2352 by 1568 pixels — 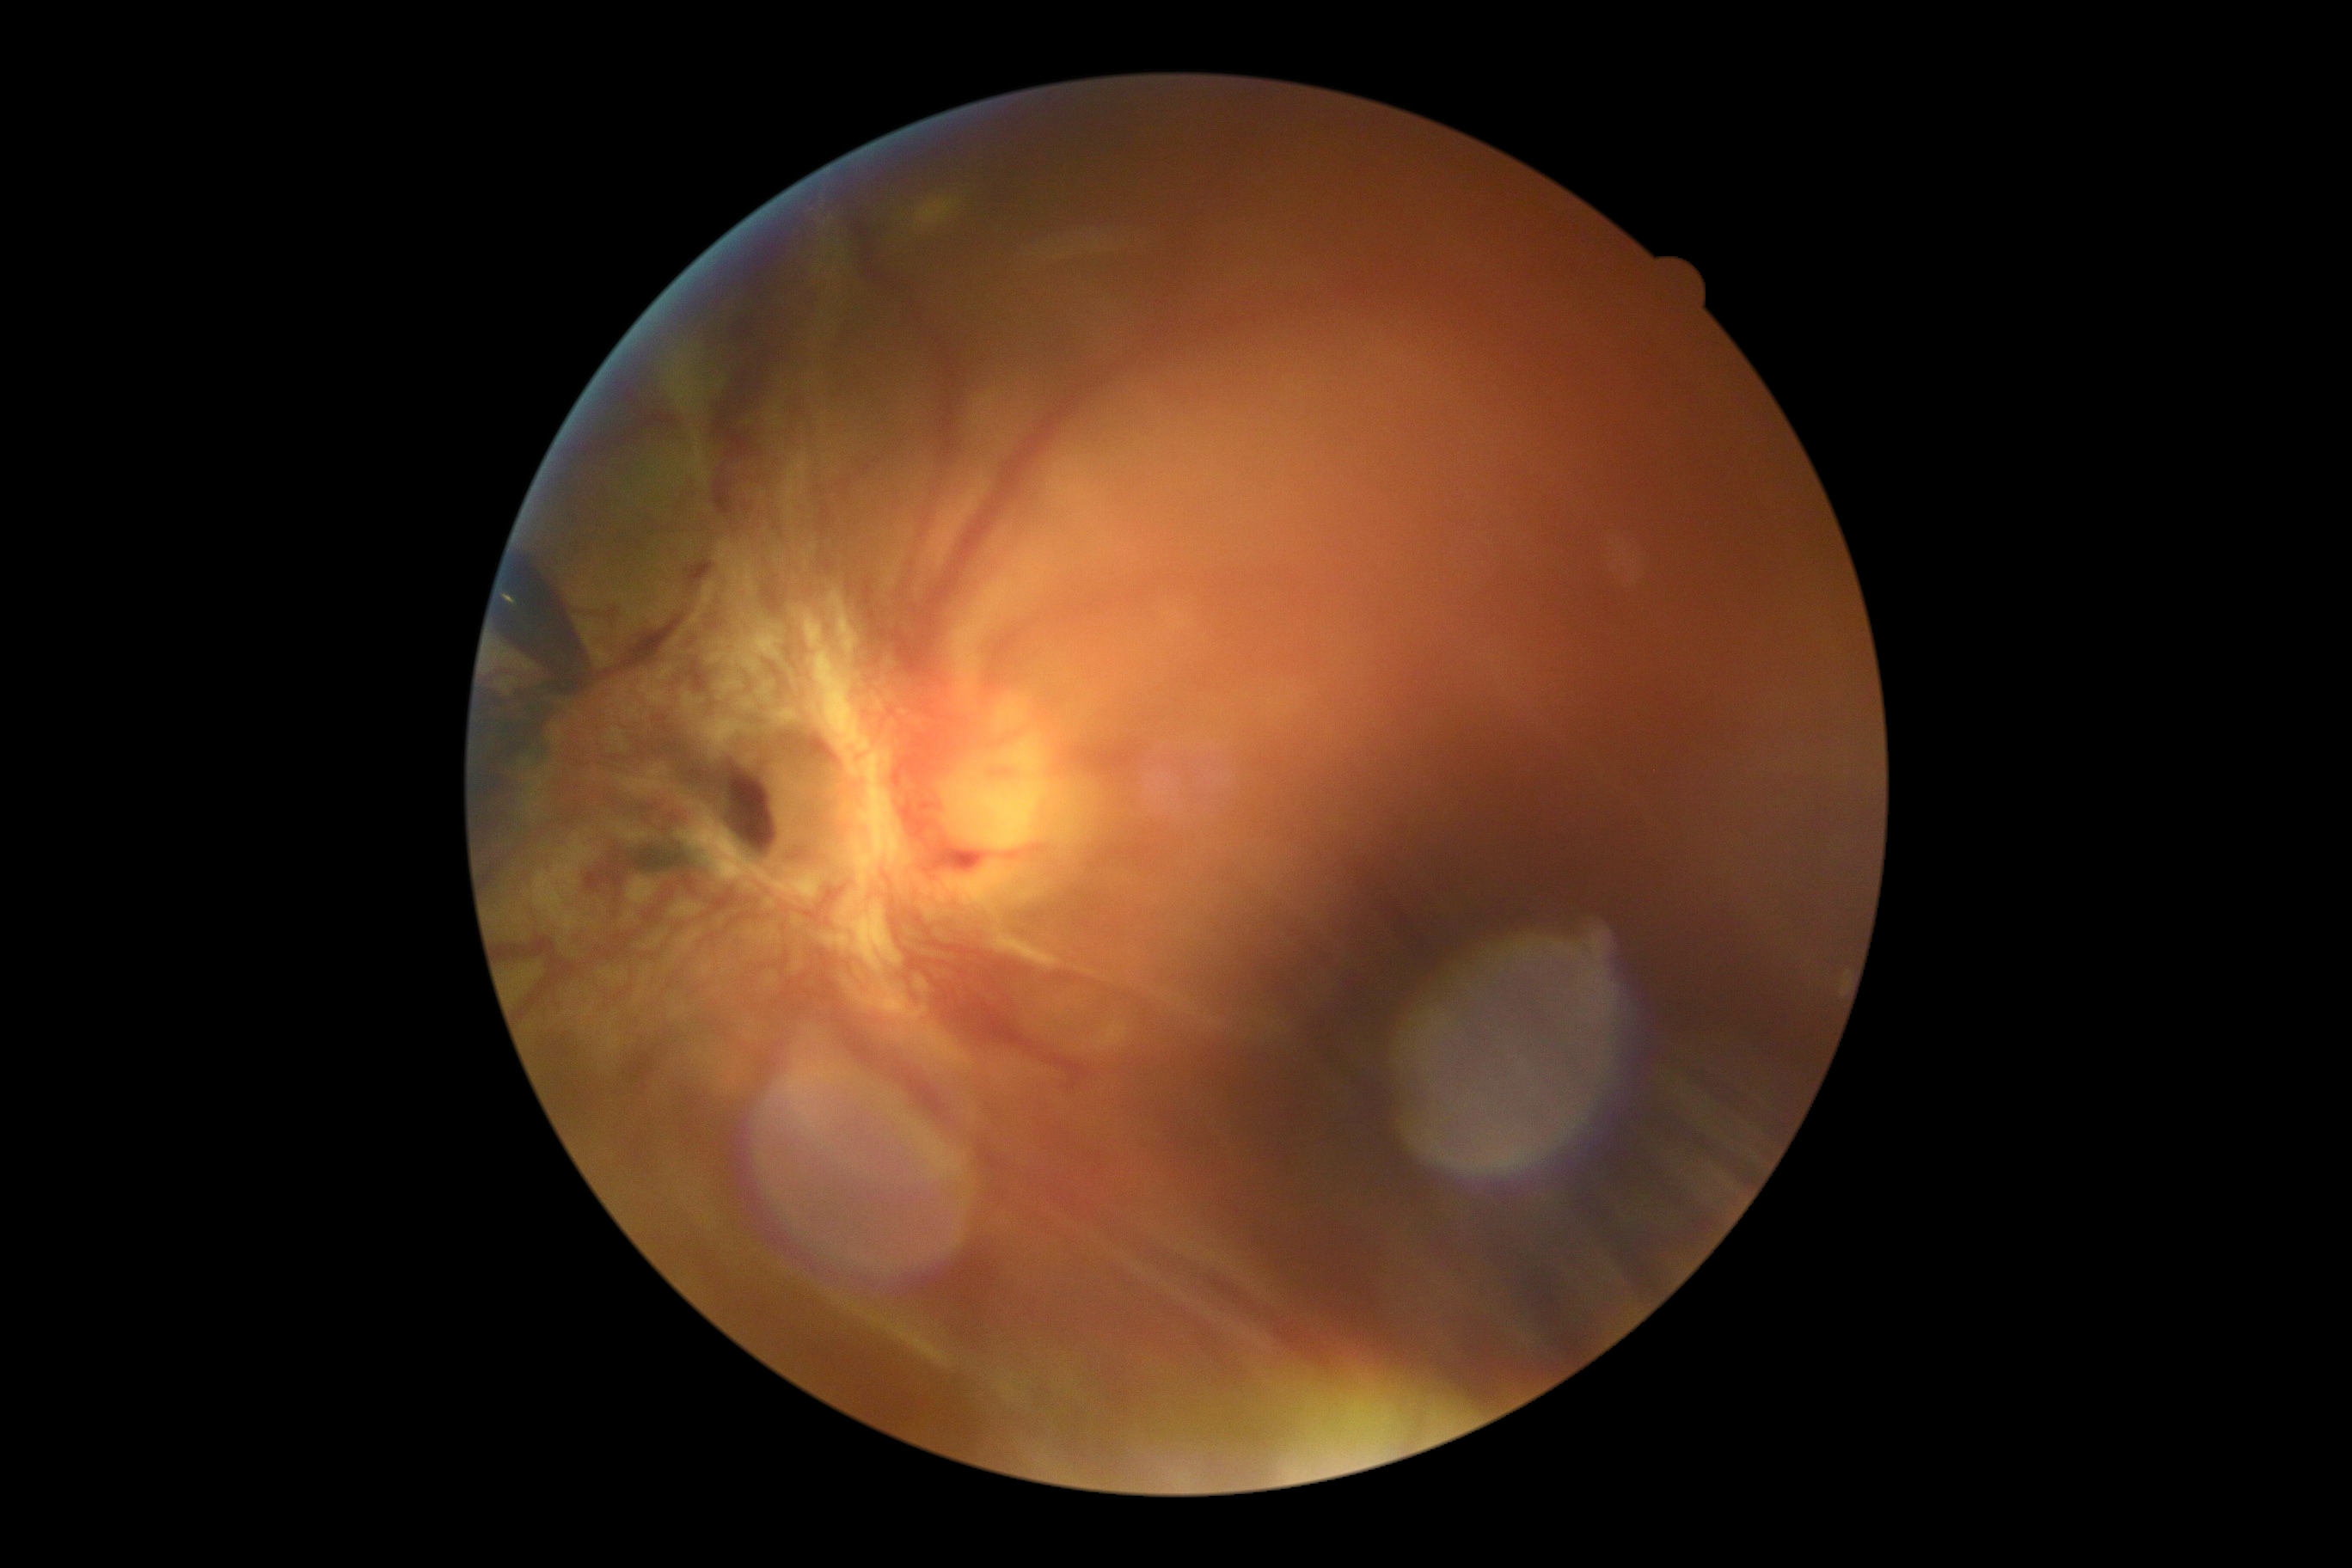
Diabetic retinopathy: grade 4 (PDR).
The retinopathy is classified as proliferative diabetic retinopathy.